Davis DR grading
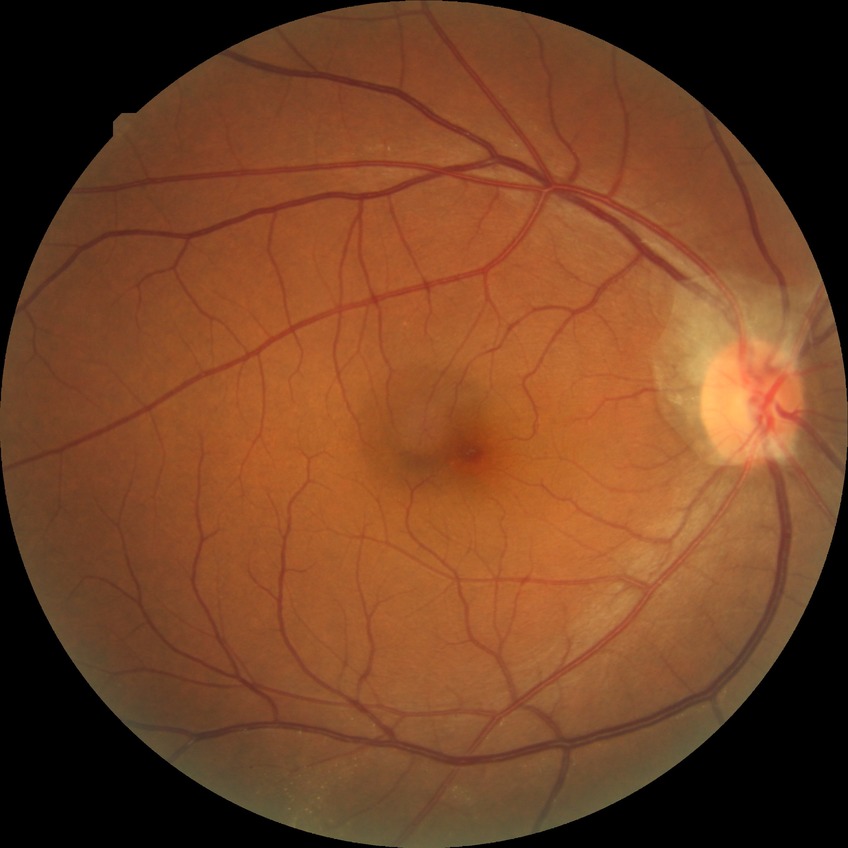
modified Davis grading = no diabetic retinopathy